Davis DR grading.
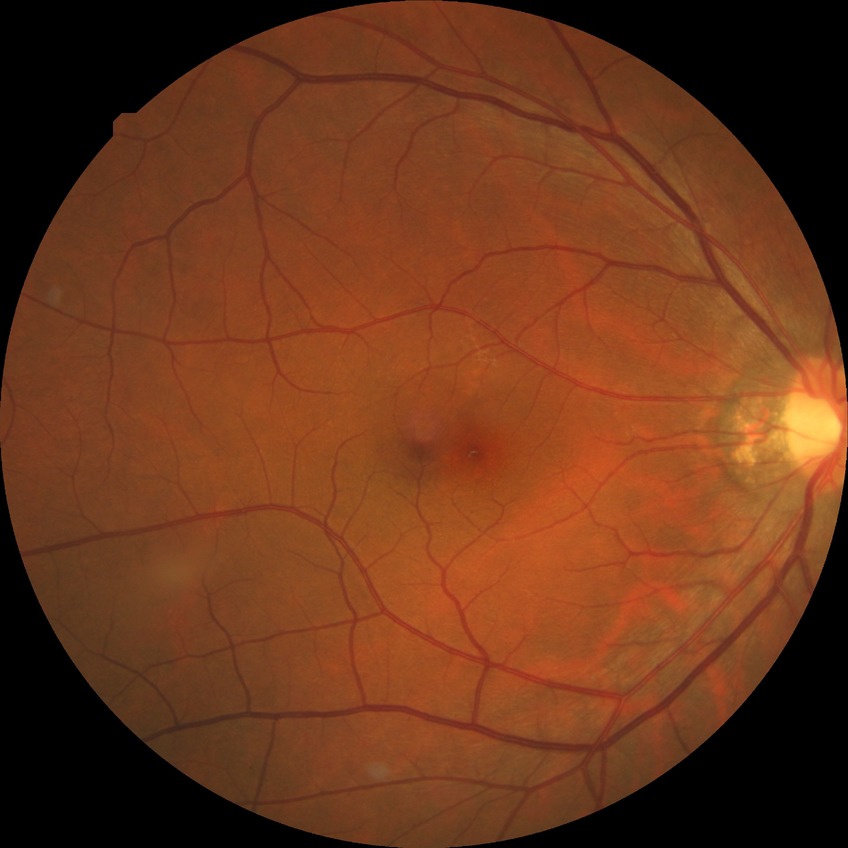
Diabetic retinopathy severity: no diabetic retinopathy.